848 by 848 pixels · acquired with a NIDEK AFC-230.
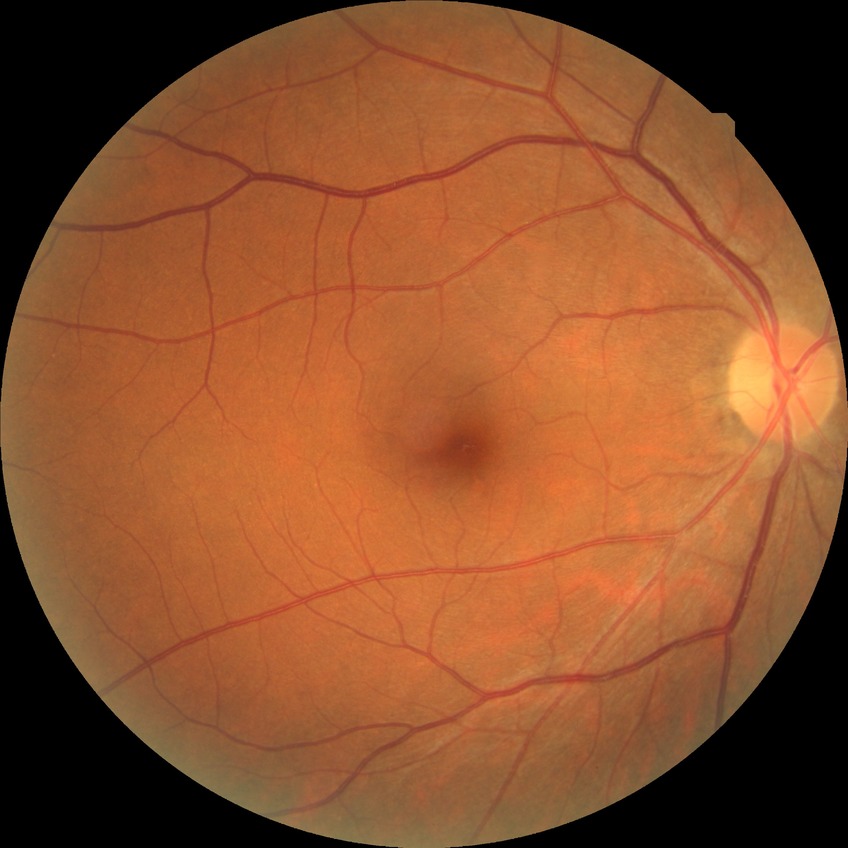 davis_grade: NDR (no diabetic retinopathy)